45° FOV:
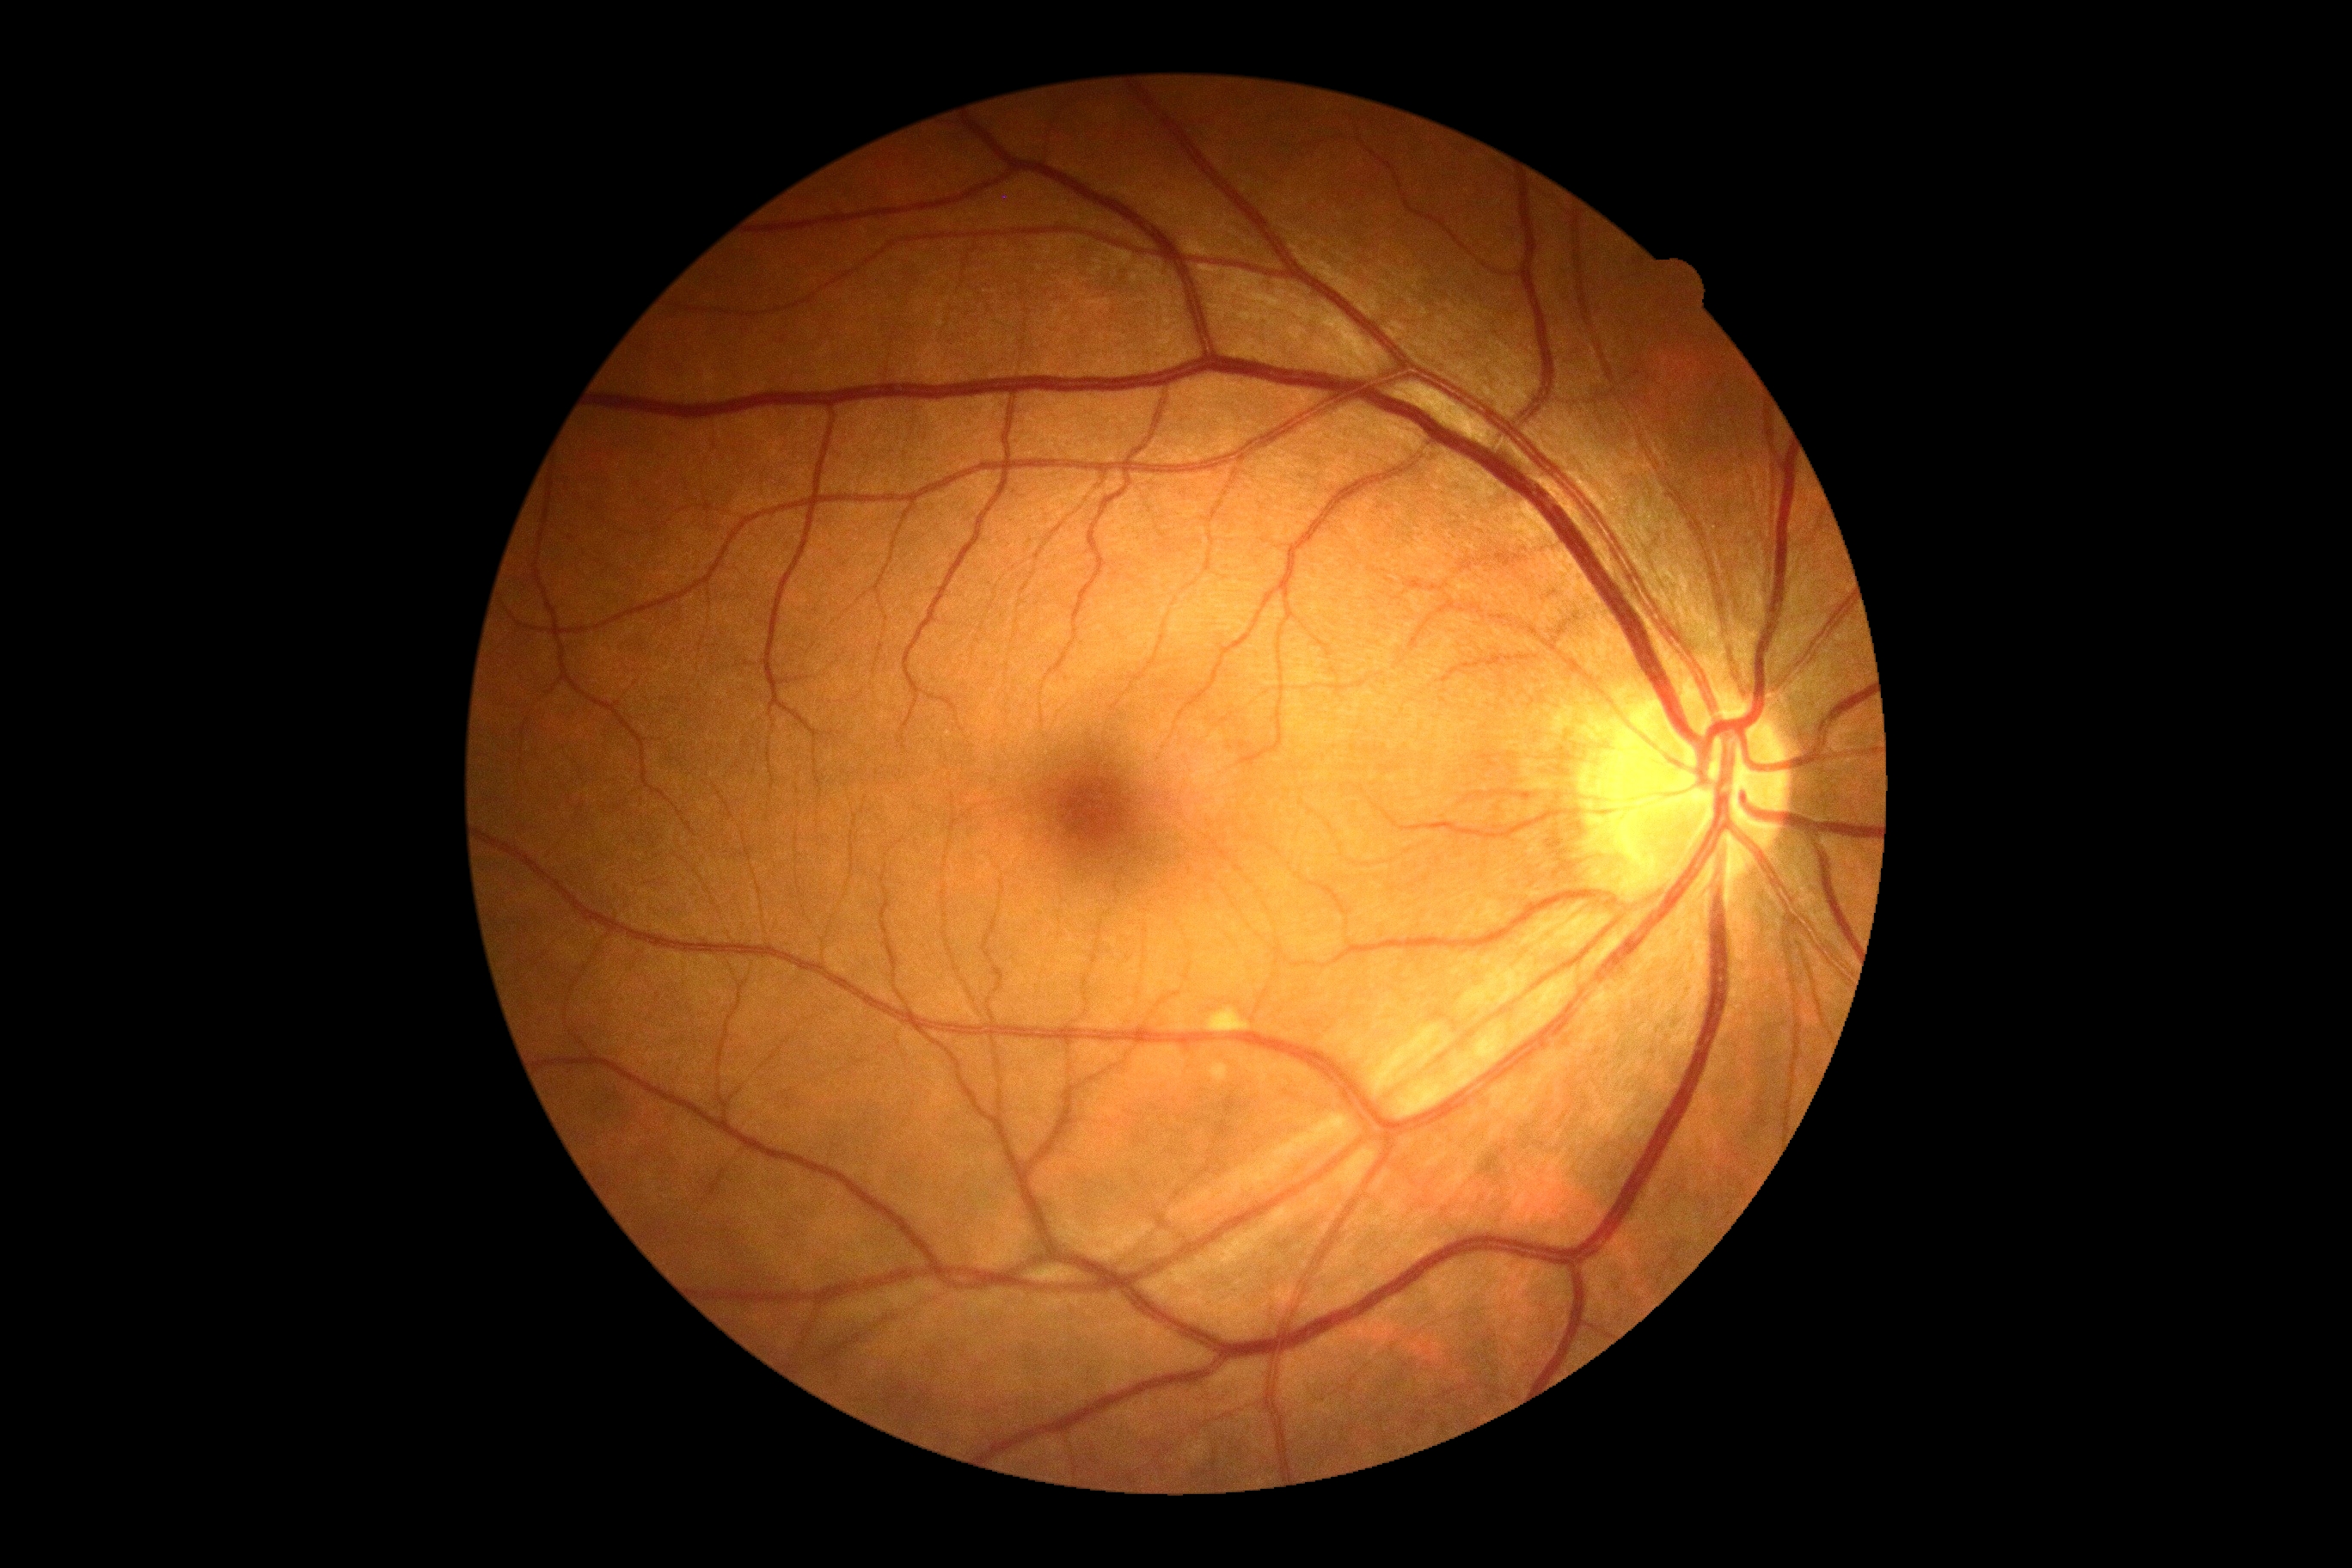
No diabetic retinal disease findings.
DR stage: no apparent diabetic retinopathy (grade 0).